2352x1568
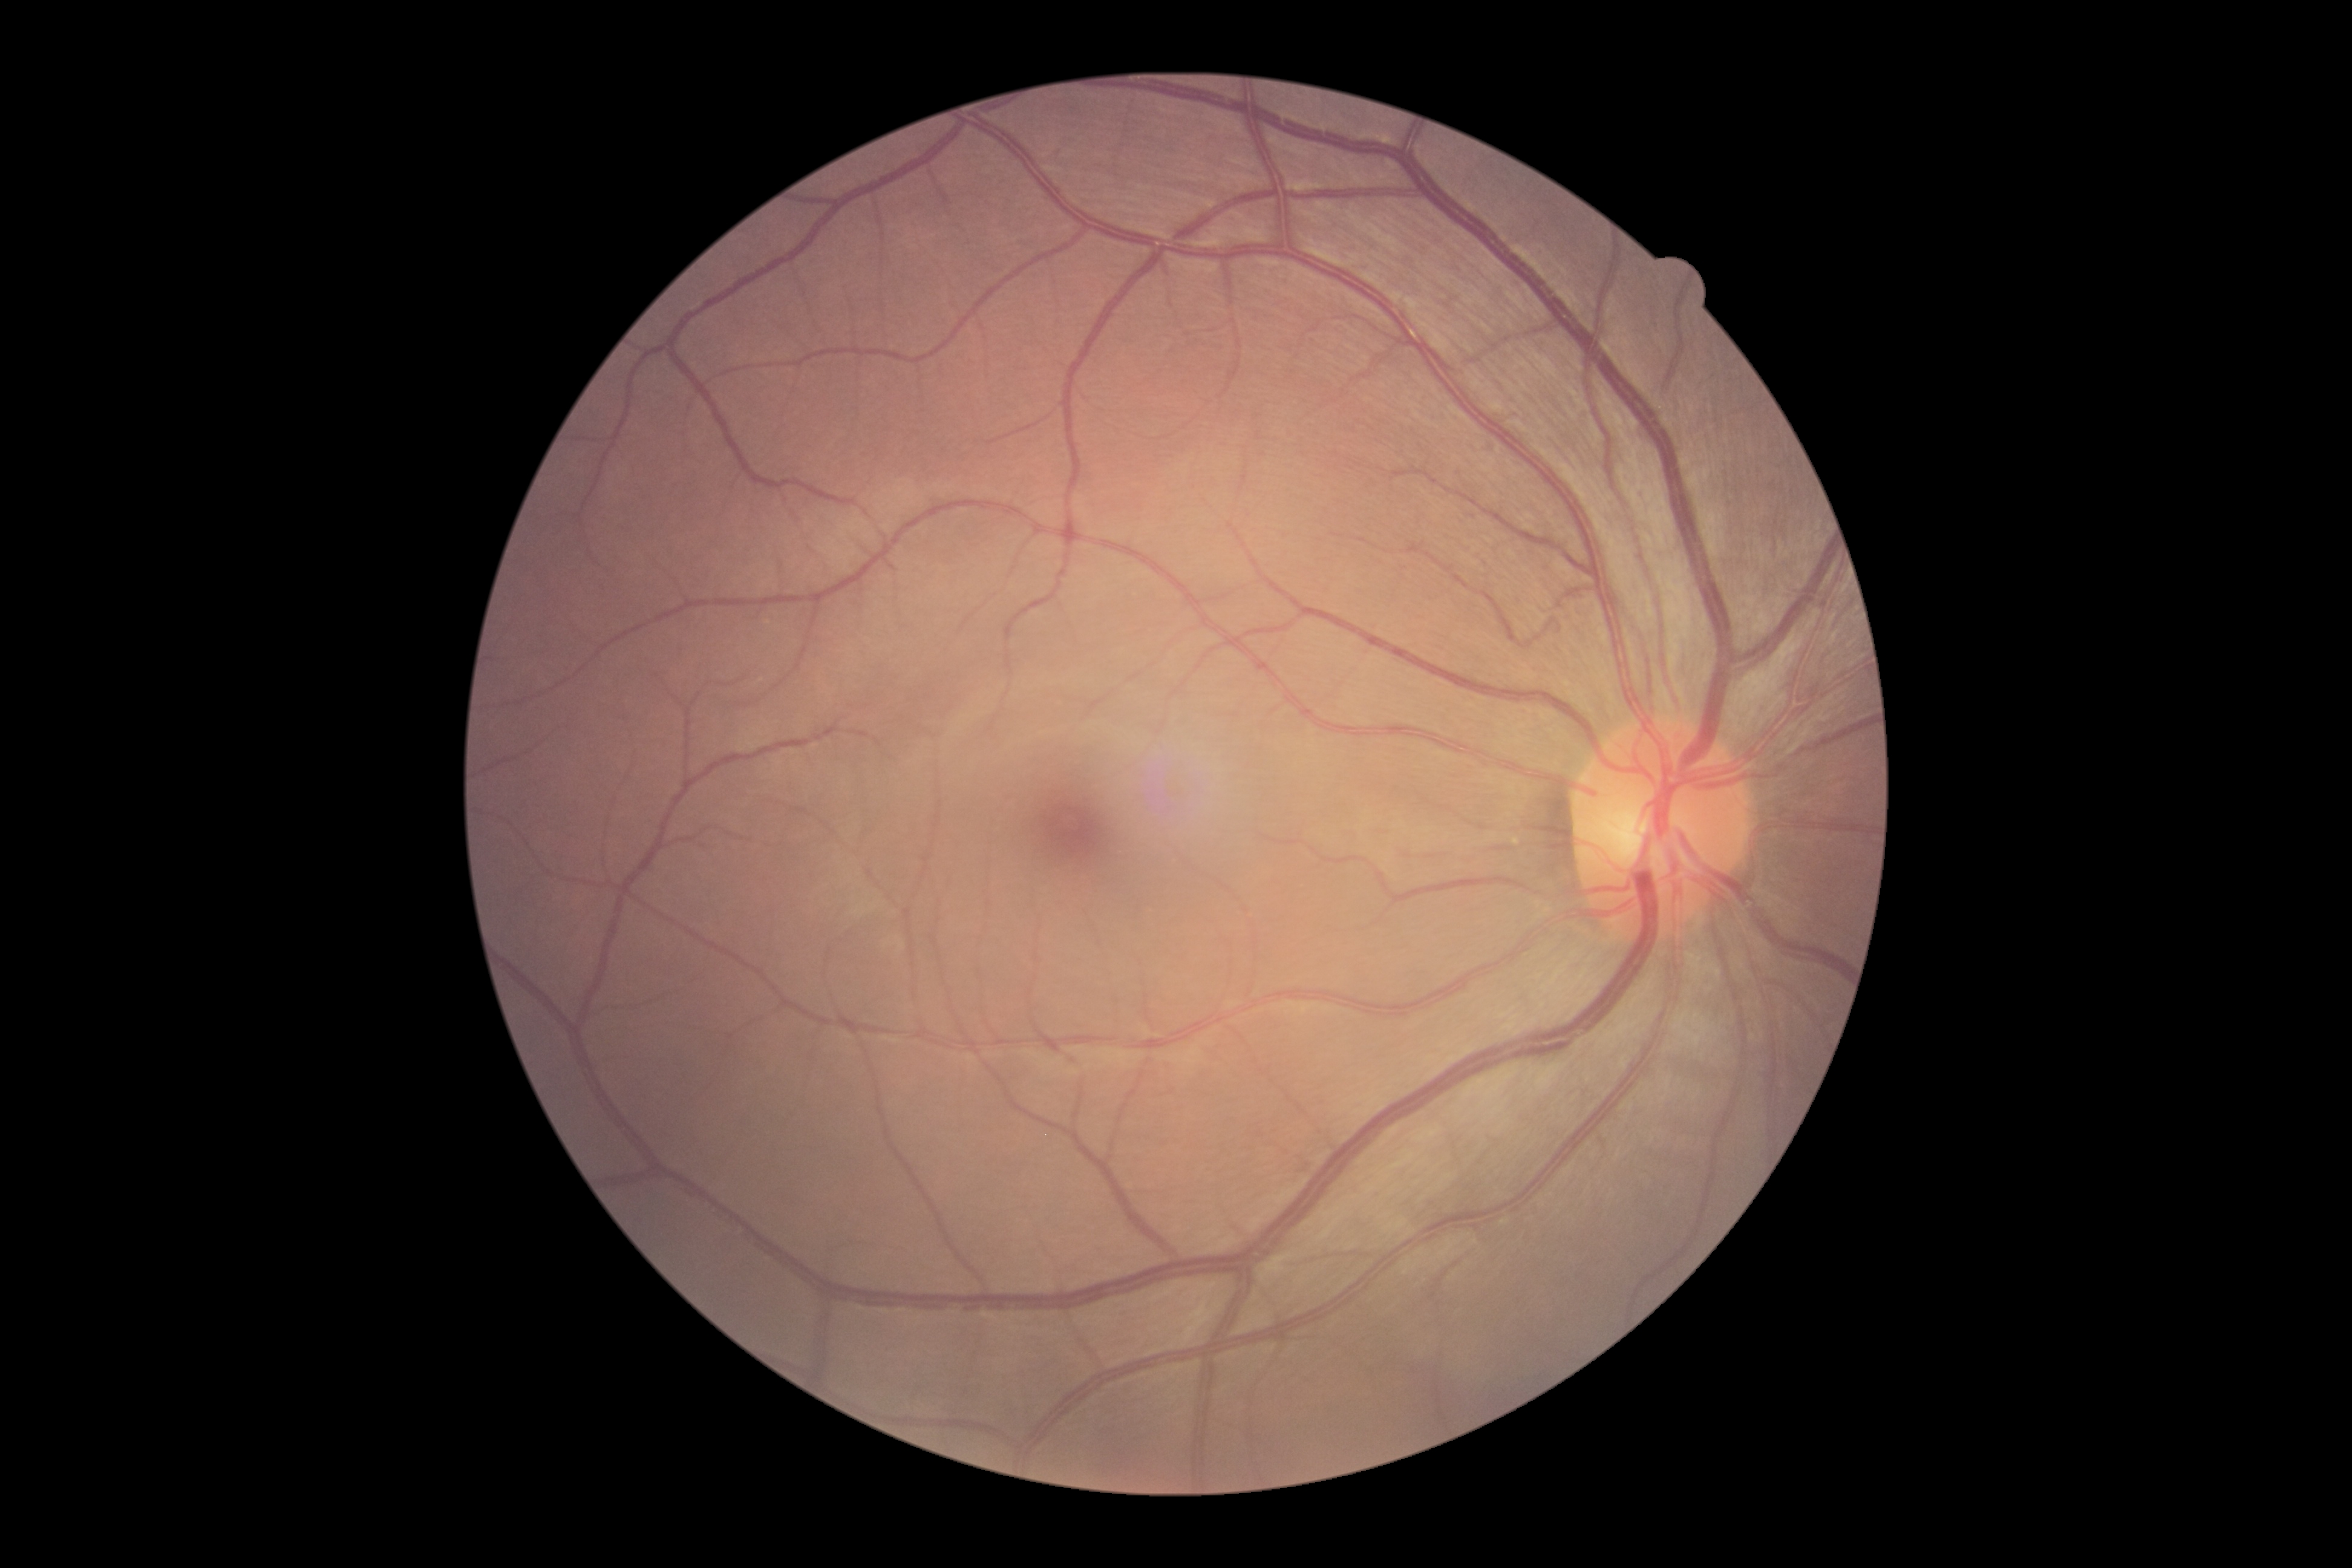
diabetic retinopathy severity@grade 0 (no apparent retinopathy).